1440 by 1080 pixels. Infant wide-field retinal image: 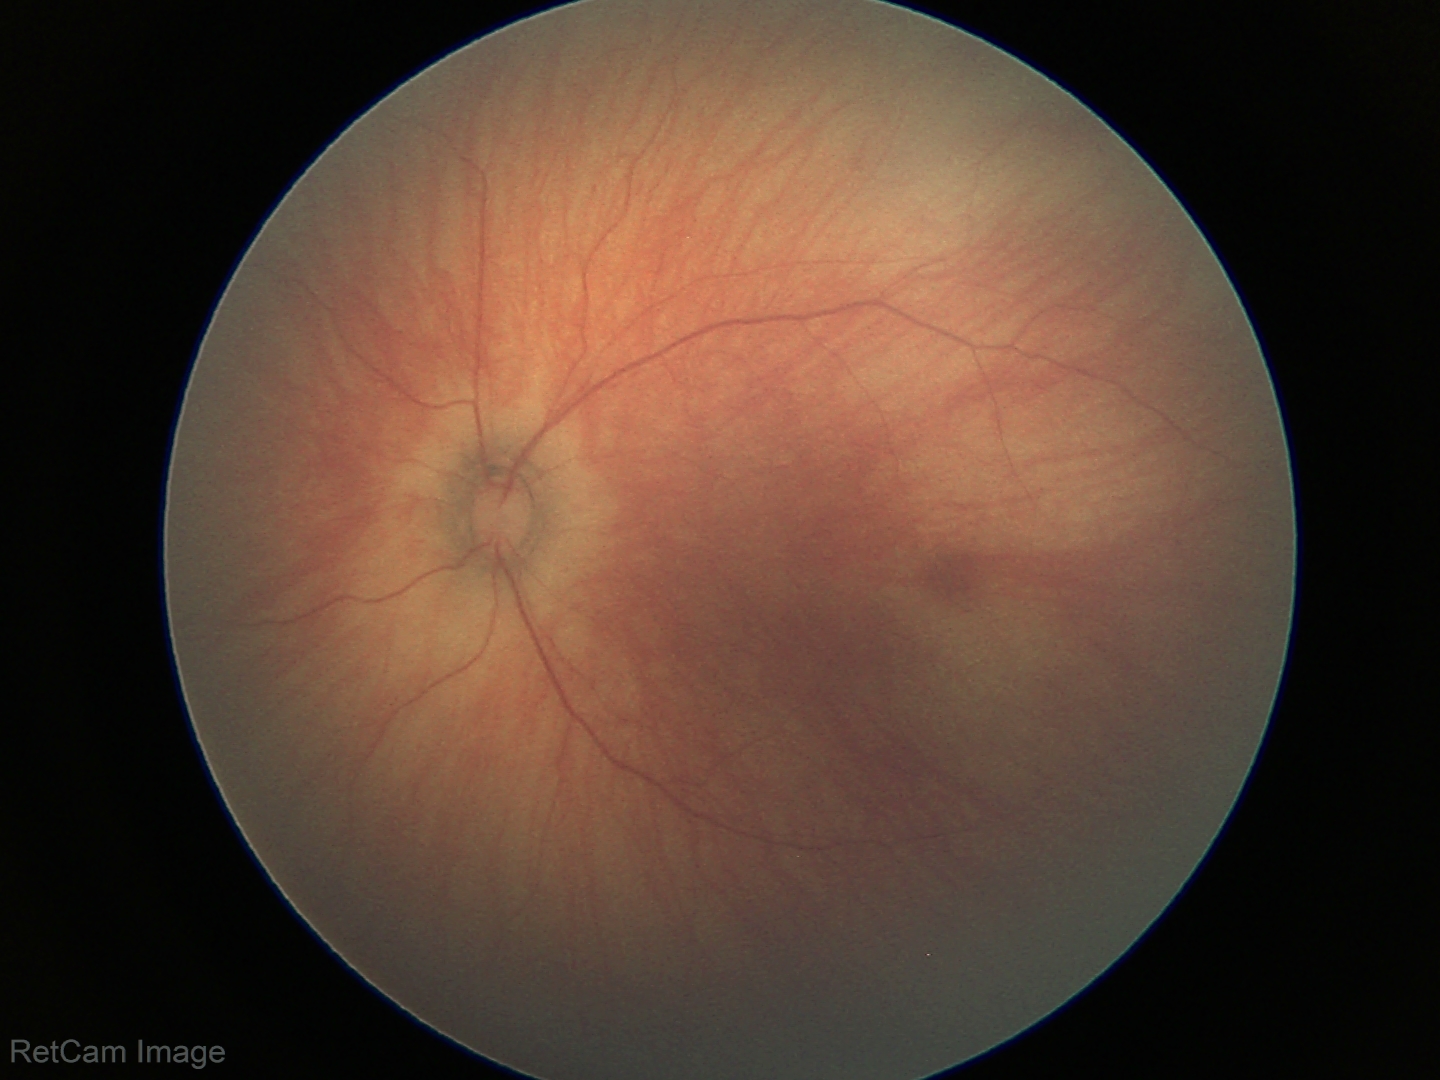
Screening examination with no abnormal retinal findings.